45° FOV:
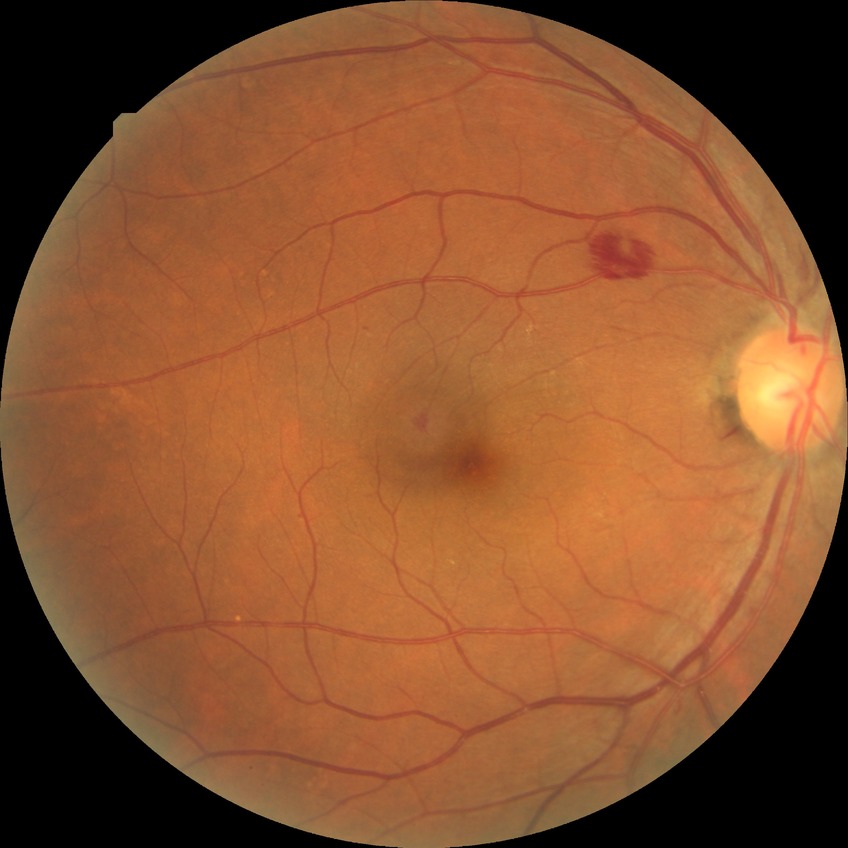 Diabetic retinopathy stage: simple diabetic retinopathy.
Disease class: non-proliferative diabetic retinopathy.